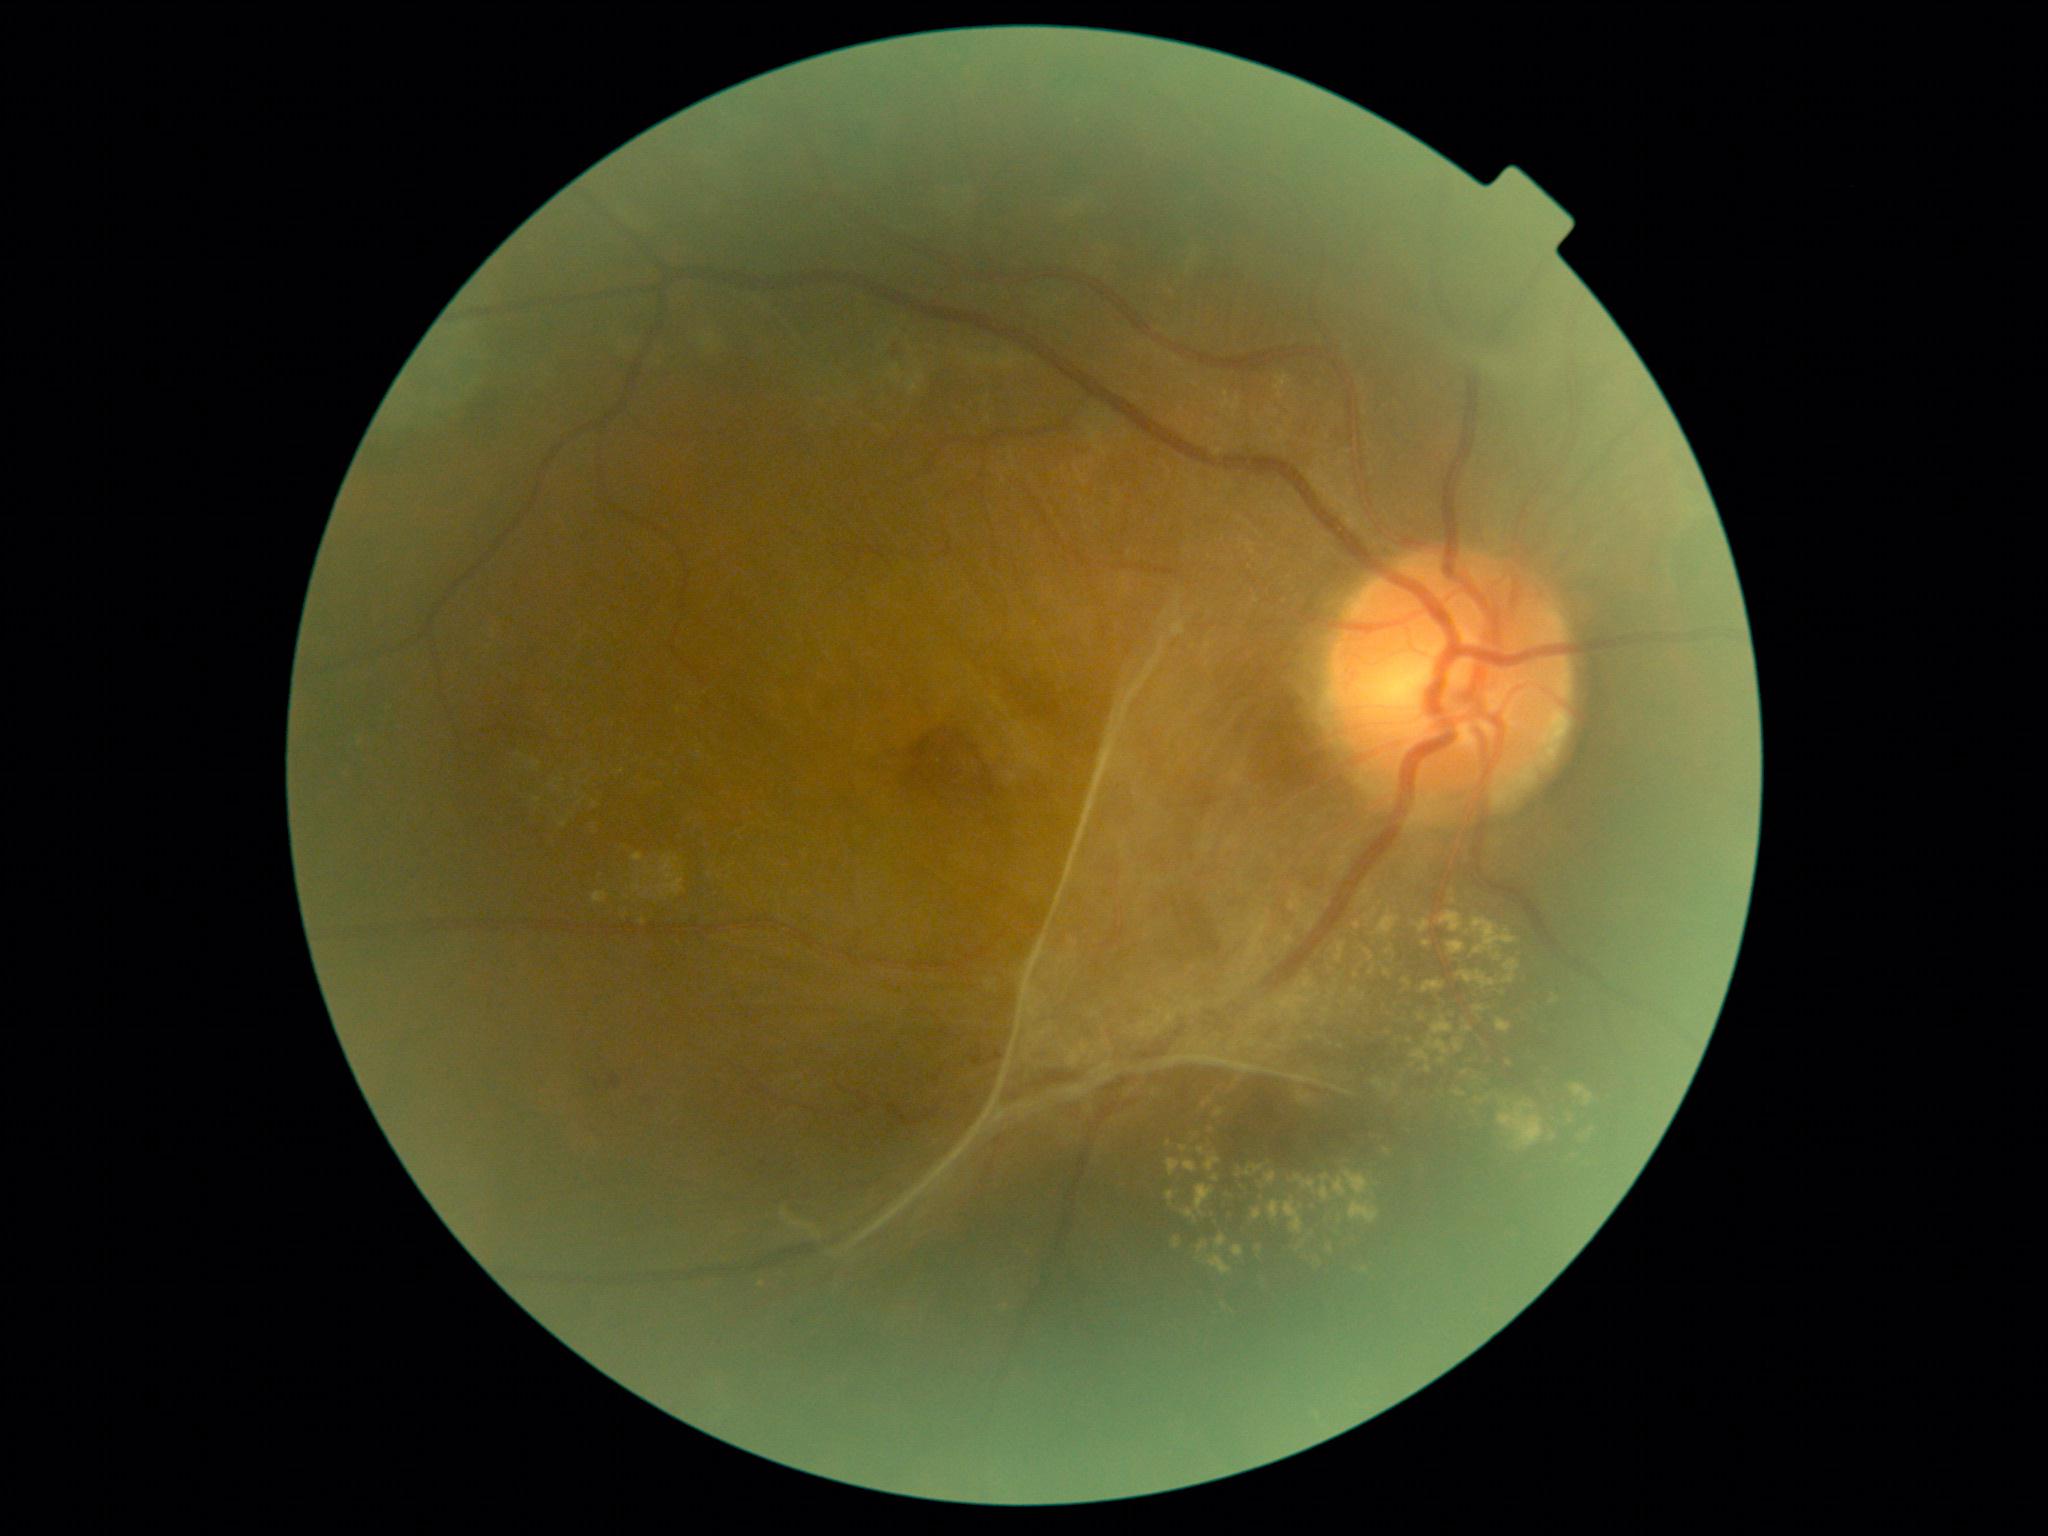
Findings:
* diabetic retinopathy — PDR (grade 4)